Retinal fundus photograph. 45-degree field of view — 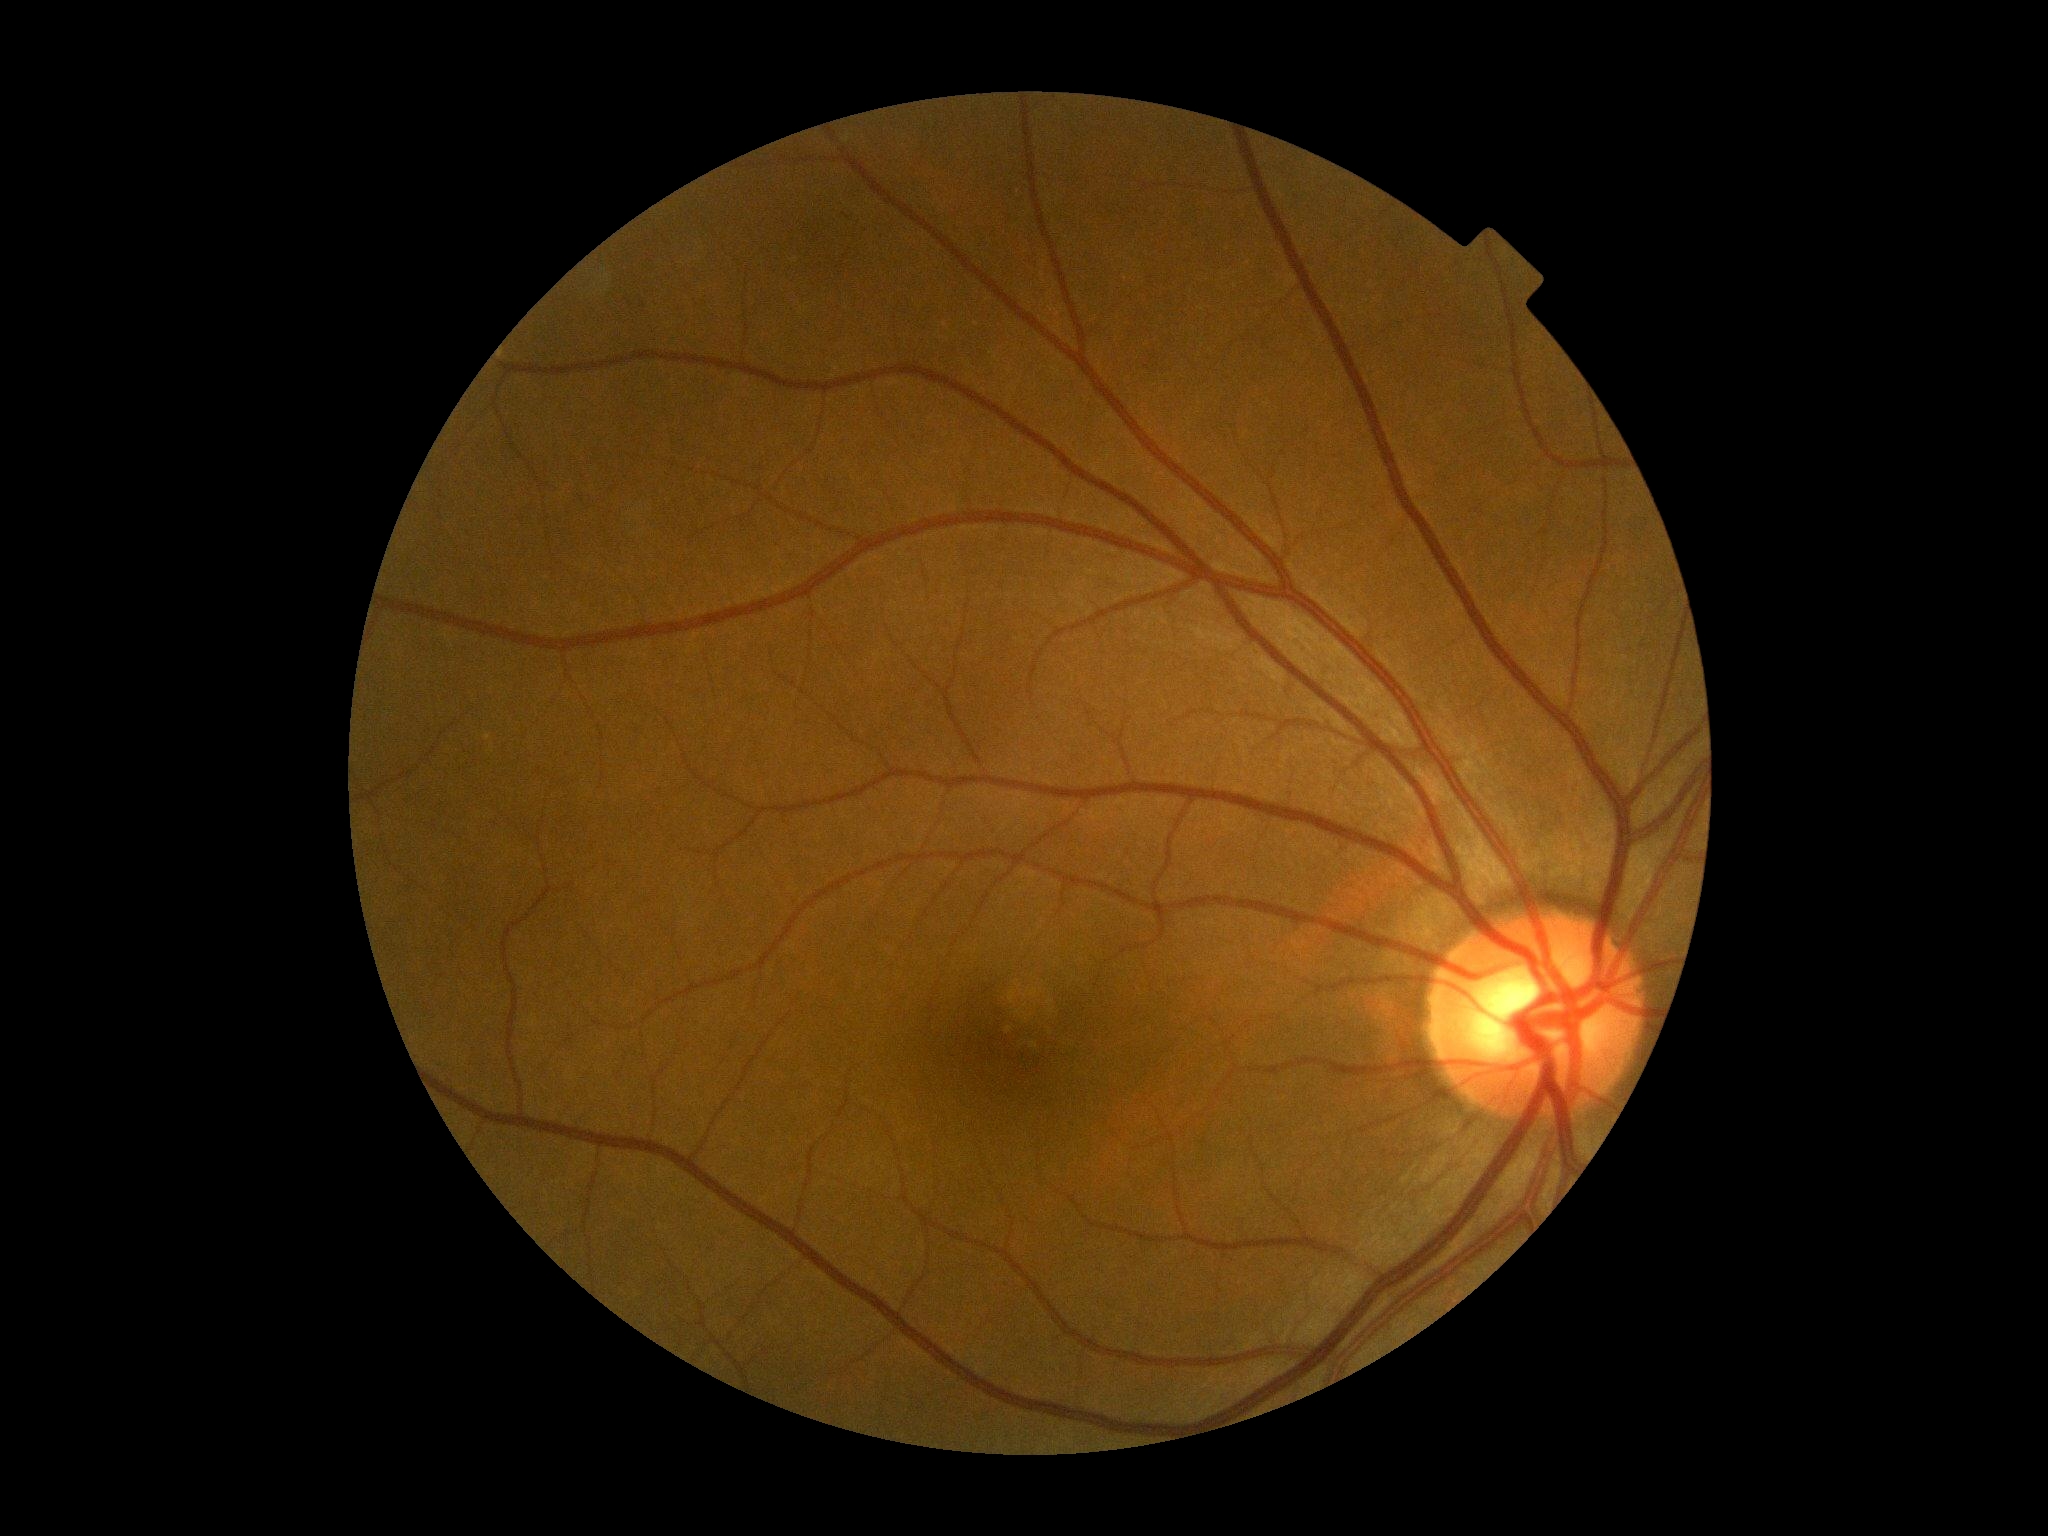

Retinopathy: grade 0 (no apparent retinopathy).